240x240px — 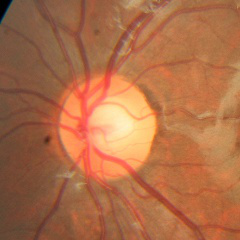 Optic nerve head appearance consistent with no glaucomatous findings.